Color fundus photograph · image size 412x310:
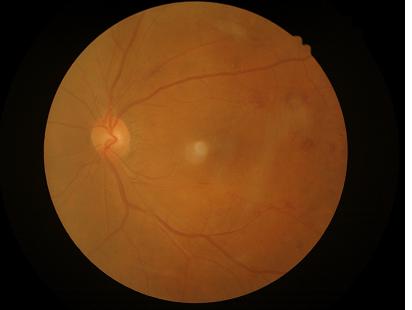
illumination: satisfactory
overall_quality: acceptable
contrast: adequate
clarity: clear